Wide-field contact fundus photograph of an infant · 100° field of view (Phoenix ICON) — 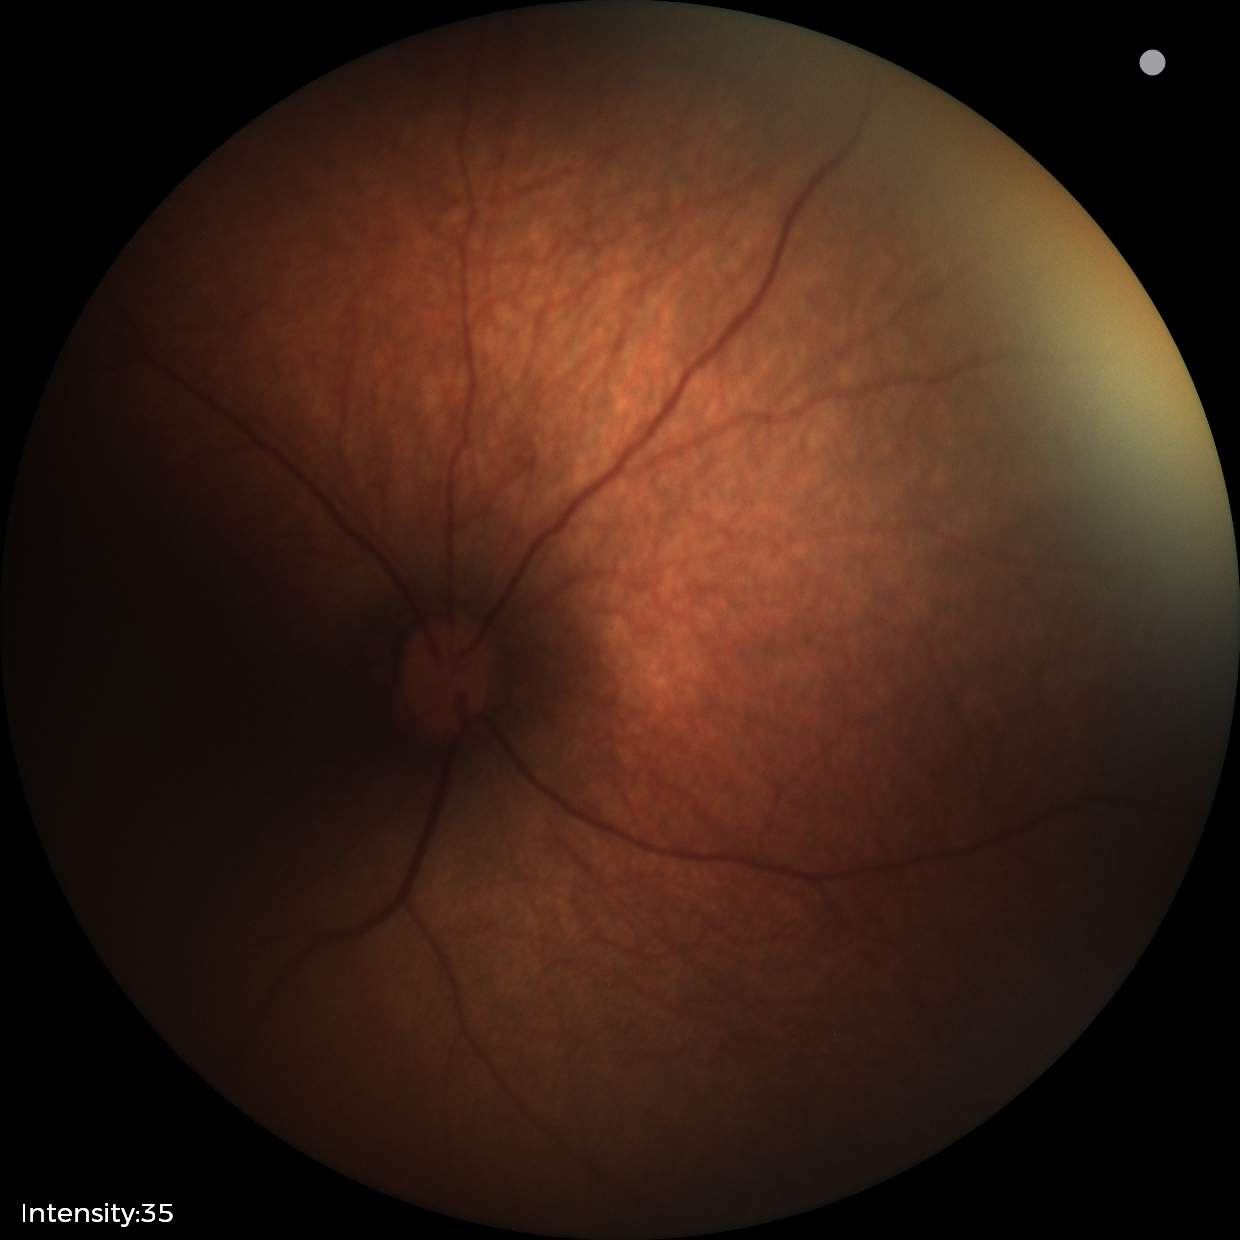

Physiological retinal appearance for postconceptual age.